1932 by 1932 pixels.
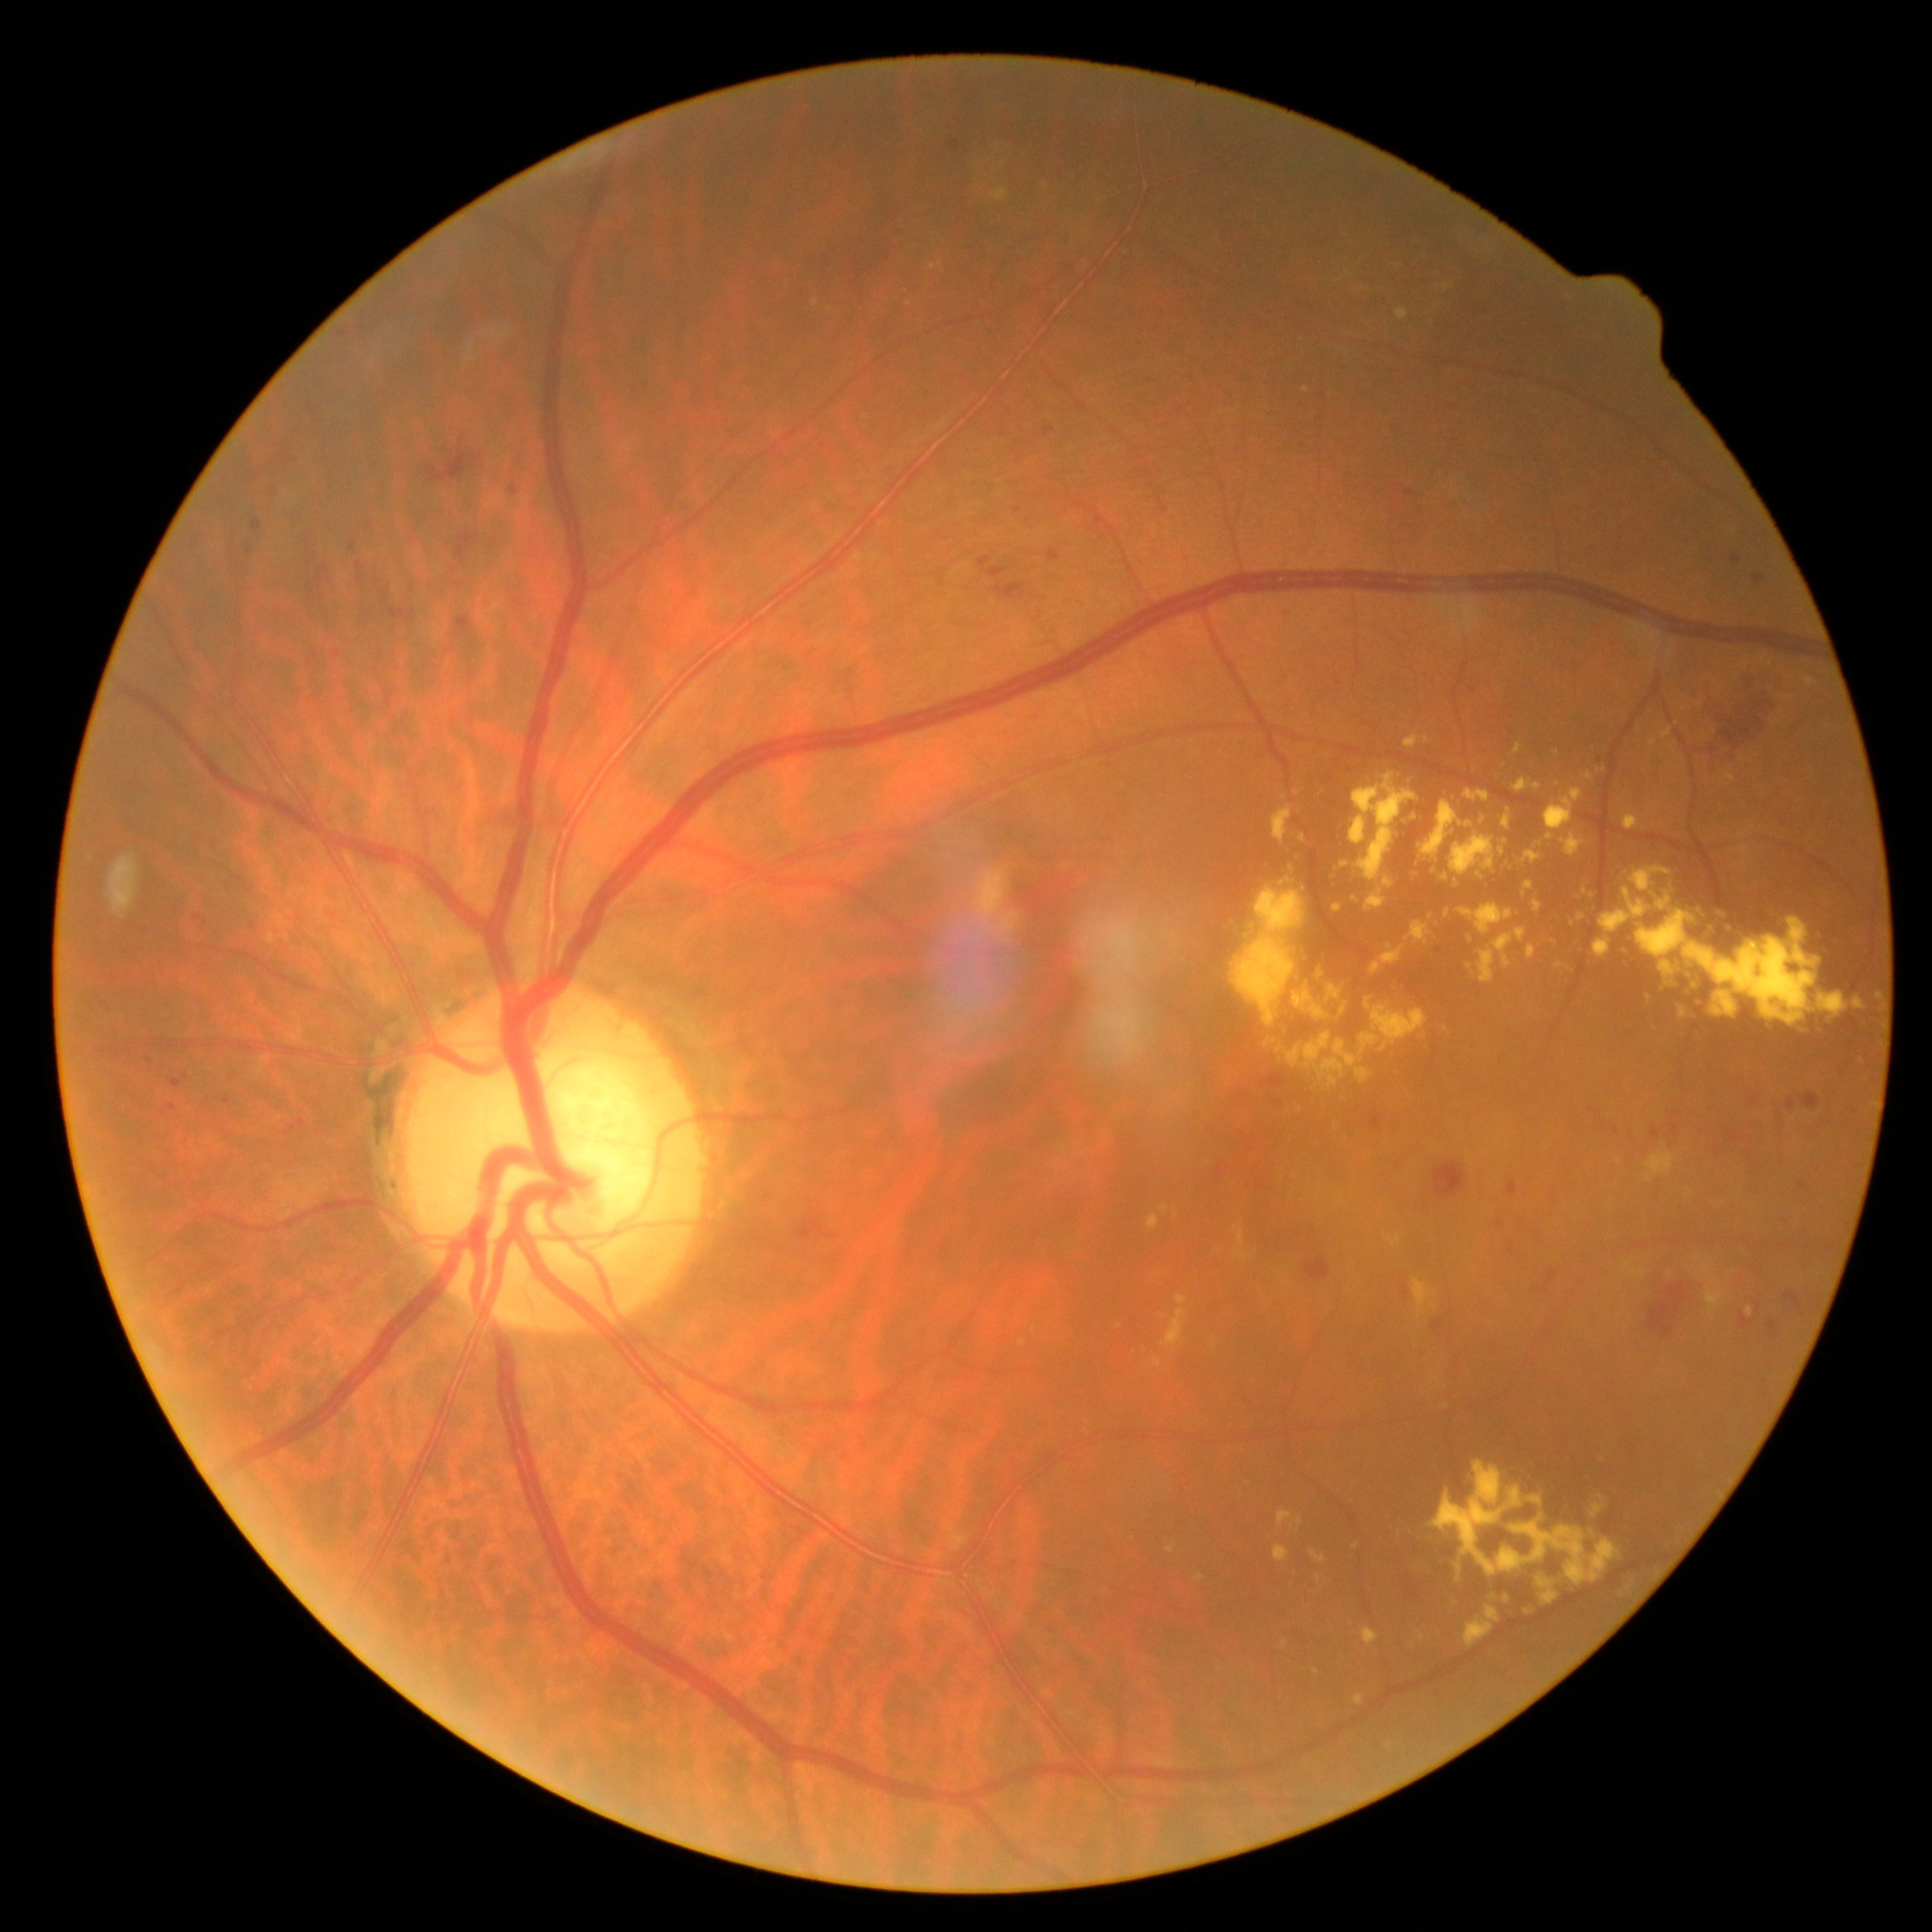

DR: grade 2. No SEs identified. HEs include those at 1450, 738, 1459, 749; 169, 1103, 178, 1111; 1662, 665, 1792, 772; 1804, 1093, 1820, 1109; 1584, 1103, 1618, 1141; 1507, 1180, 1518, 1195; 1787, 1097, 1795, 1111; 1370, 293, 1388, 310; 285, 1125, 297, 1135; 1420, 1100, 1433, 1114; 262, 480, 279, 503; 1006, 411, 1014, 416; 333, 651, 340, 659; 250, 473, 259, 477. Additional small HEs near <pt>1511,732</pt>; <pt>185,1076</pt>; <pt>309,584</pt>. EXs include those at 1161, 1309, 1190, 1350; 1311, 1549, 1327, 1562; 1278, 1508, 1293, 1528; 1312, 1669, 1320, 1675; 1624, 1262, 1647, 1277; 1660, 727, 1672, 740; 1154, 1357, 1163, 1368; 1211, 774, 1886, 1112; 1418, 1631, 1426, 1640; 1805, 678, 1816, 686; 1728, 775, 1736, 781. Additional small EXs near <pt>1342,1197</pt>; <pt>1119,1325</pt>; <pt>1711,1312</pt>; <pt>1445,1407</pt>; <pt>1035,1330</pt>; <pt>1306,390</pt>. No MAs identified.